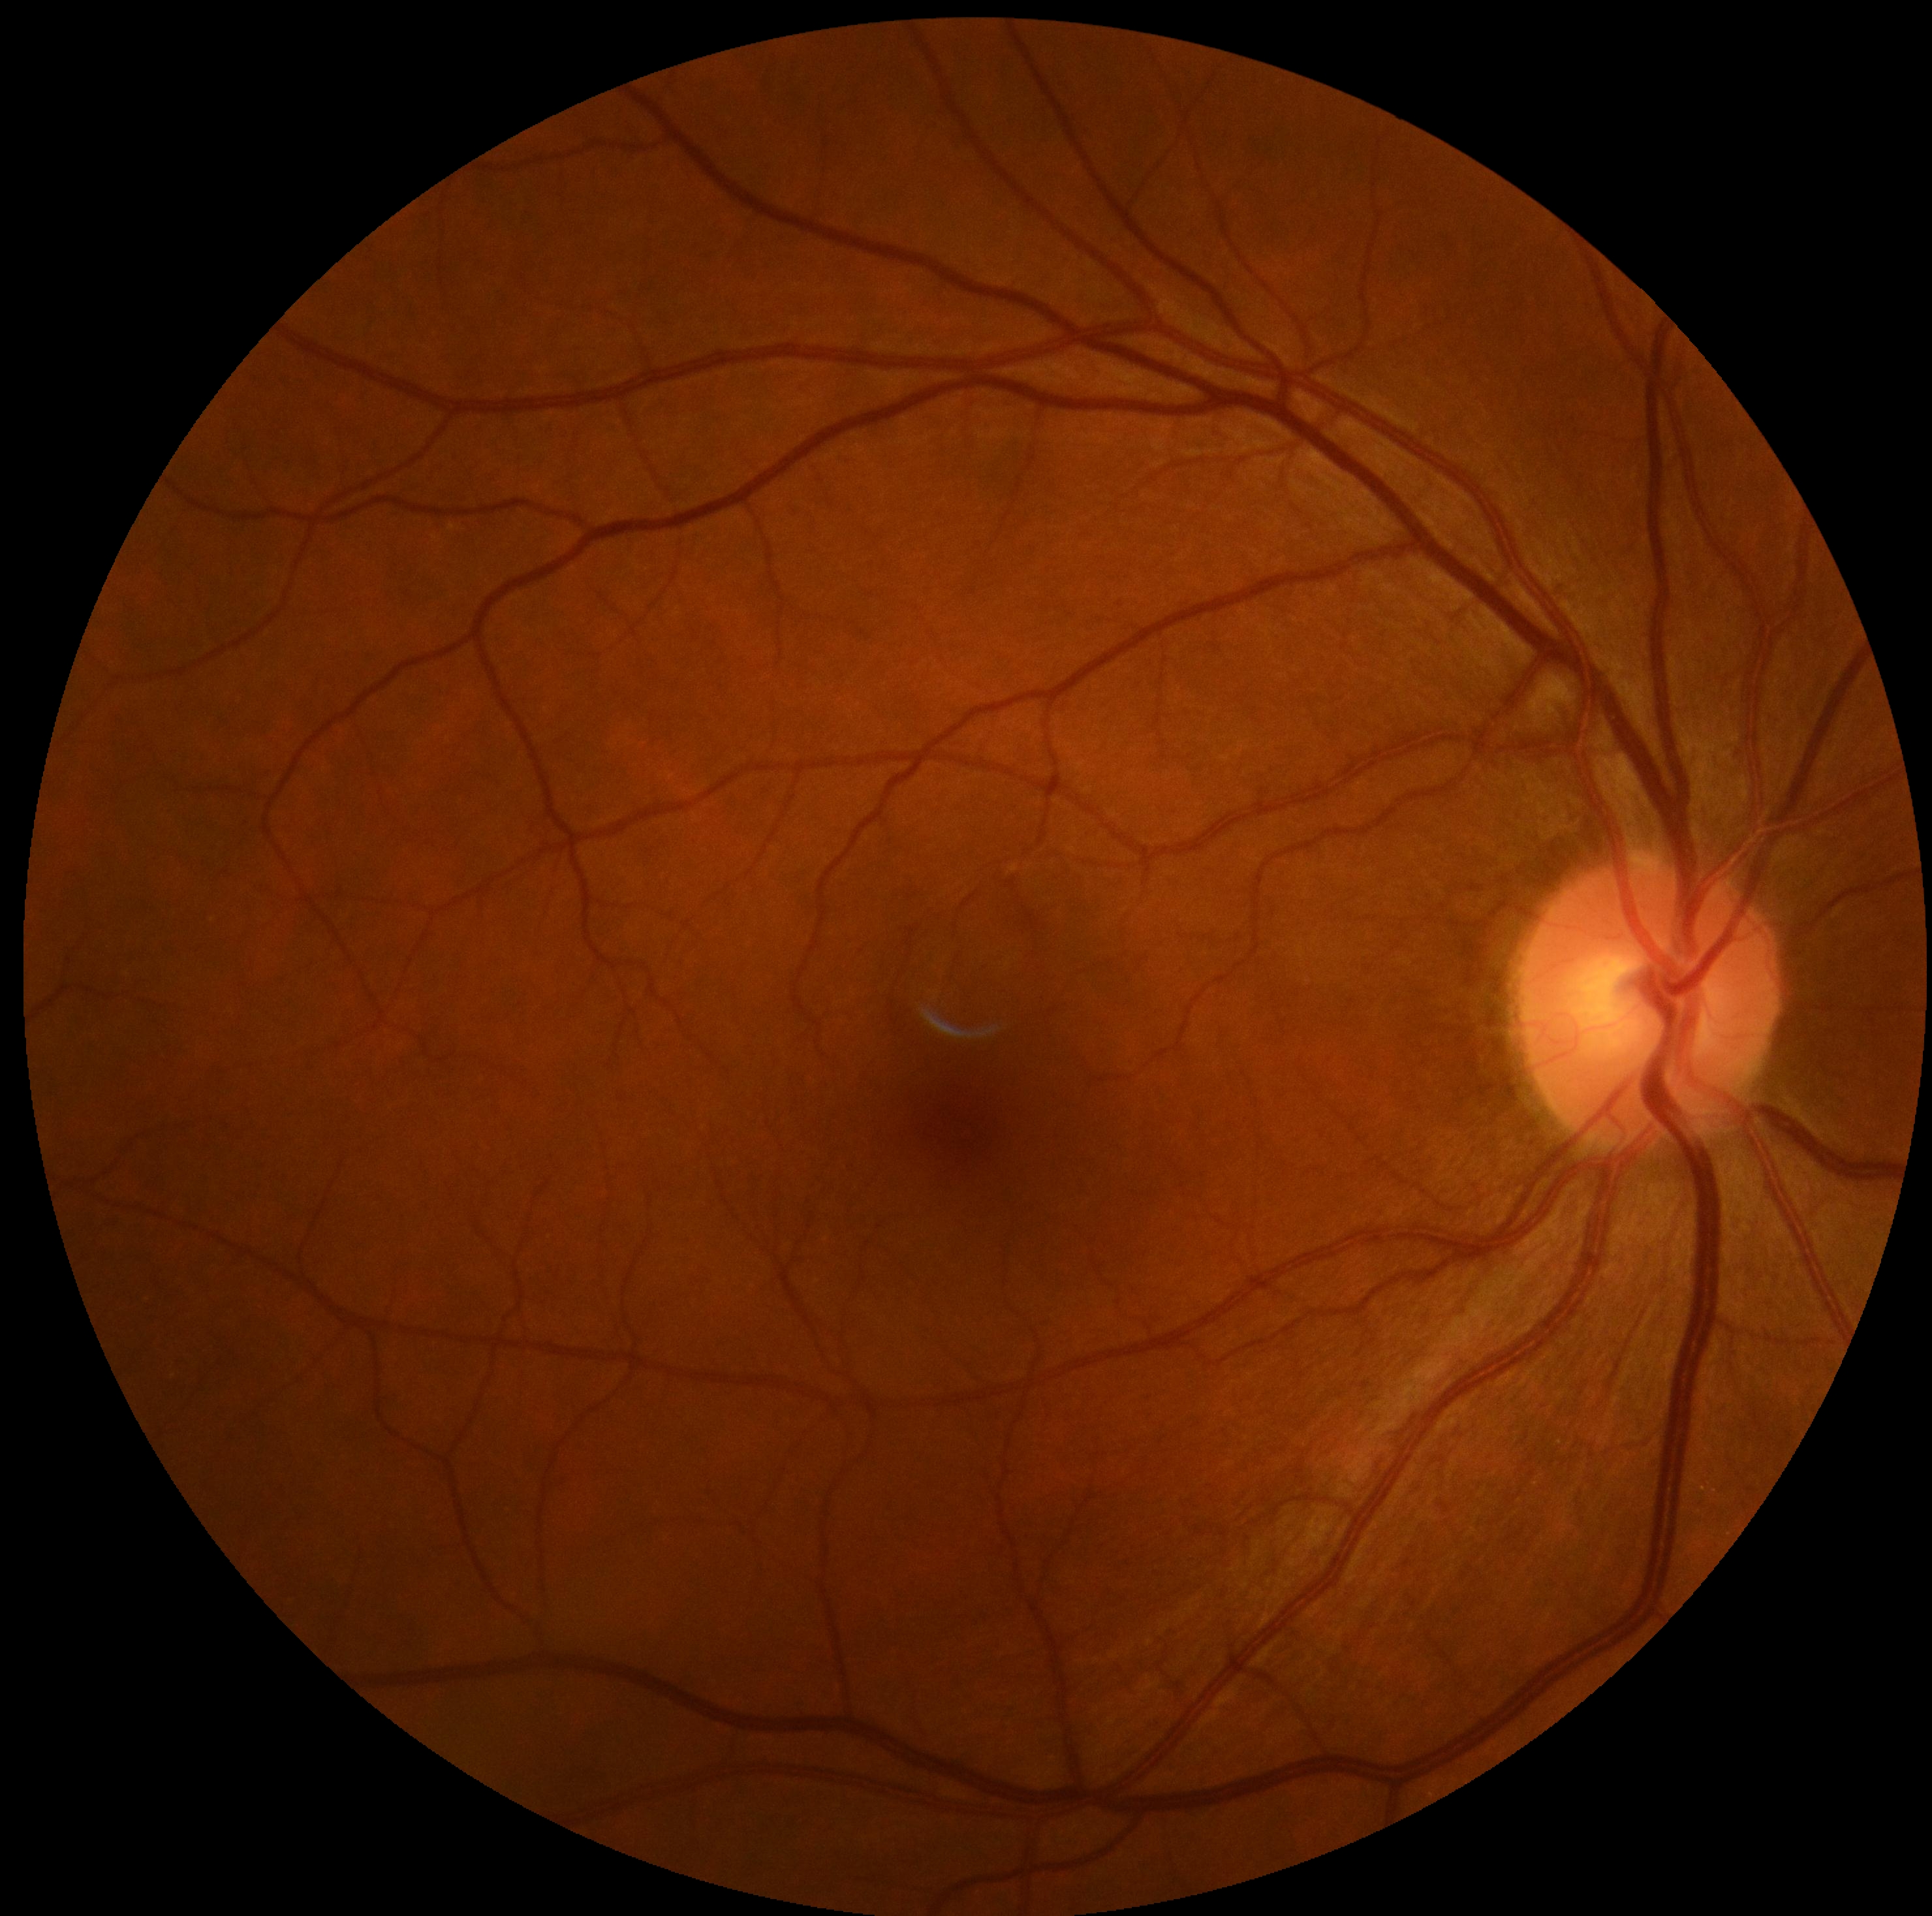 DR grade: 0 (no apparent retinopathy). No diabetic retinal disease findings.